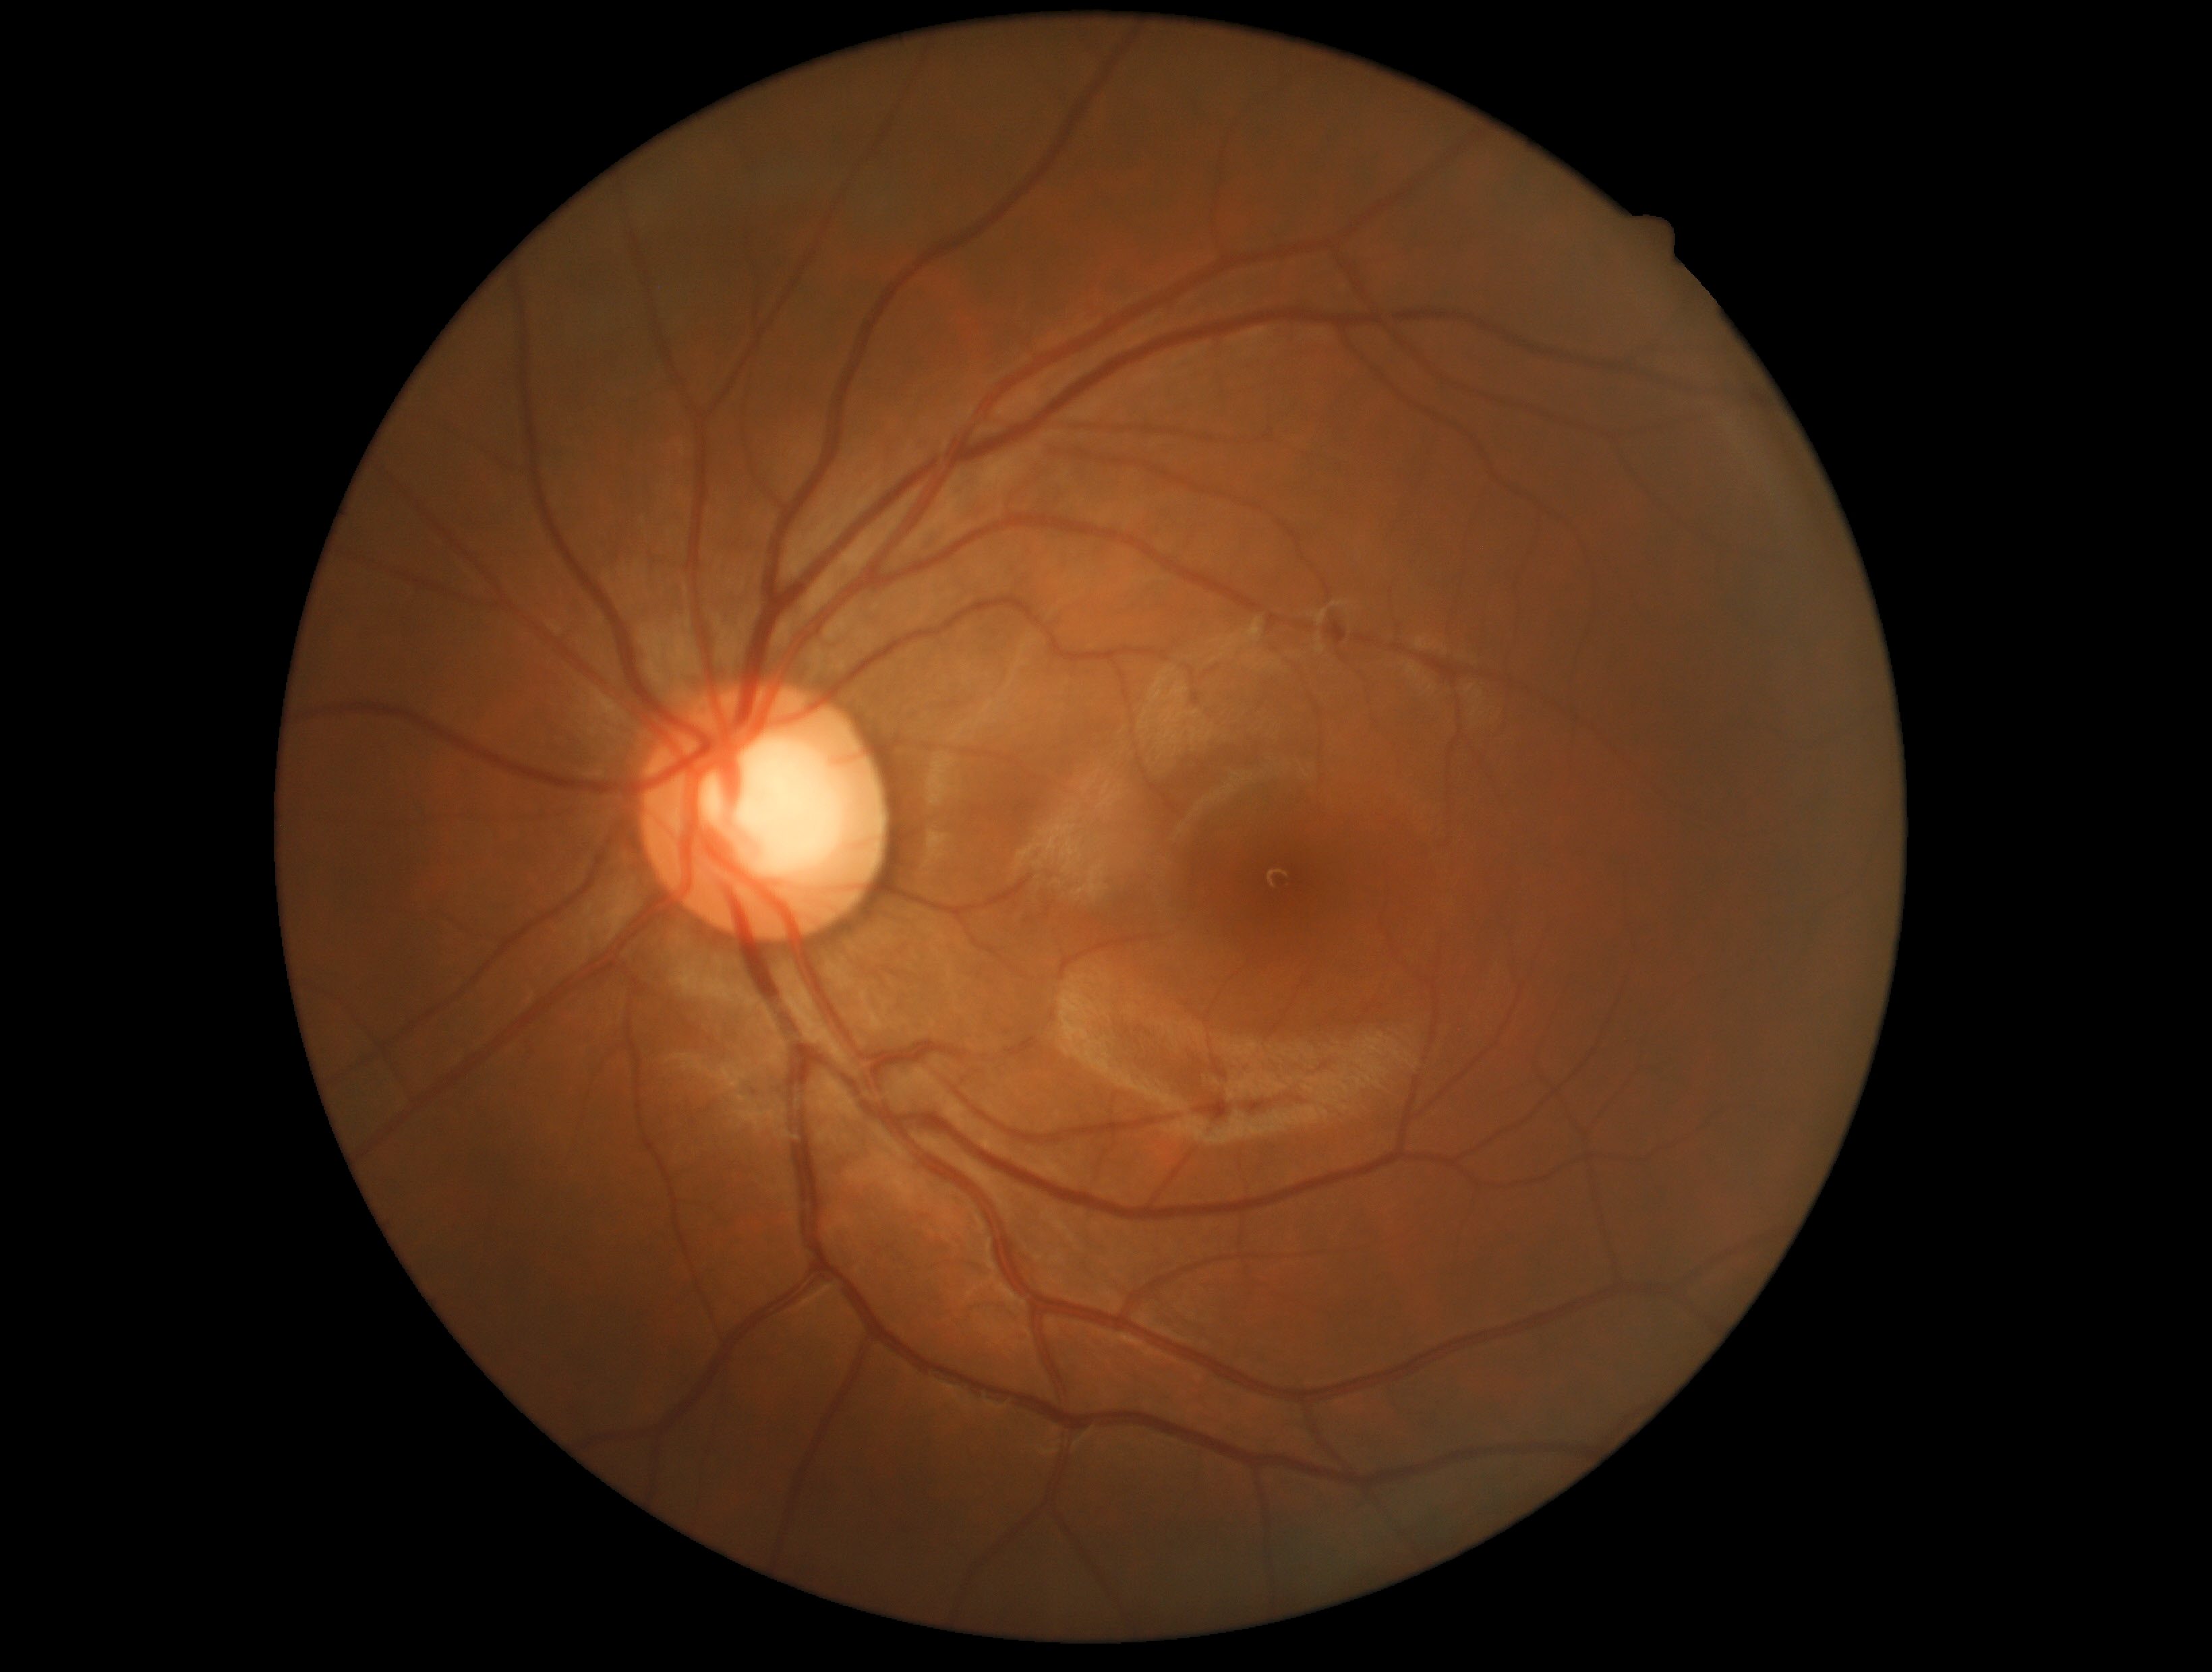 DR grade is 0 (no apparent retinopathy).